Retinal fundus photograph: 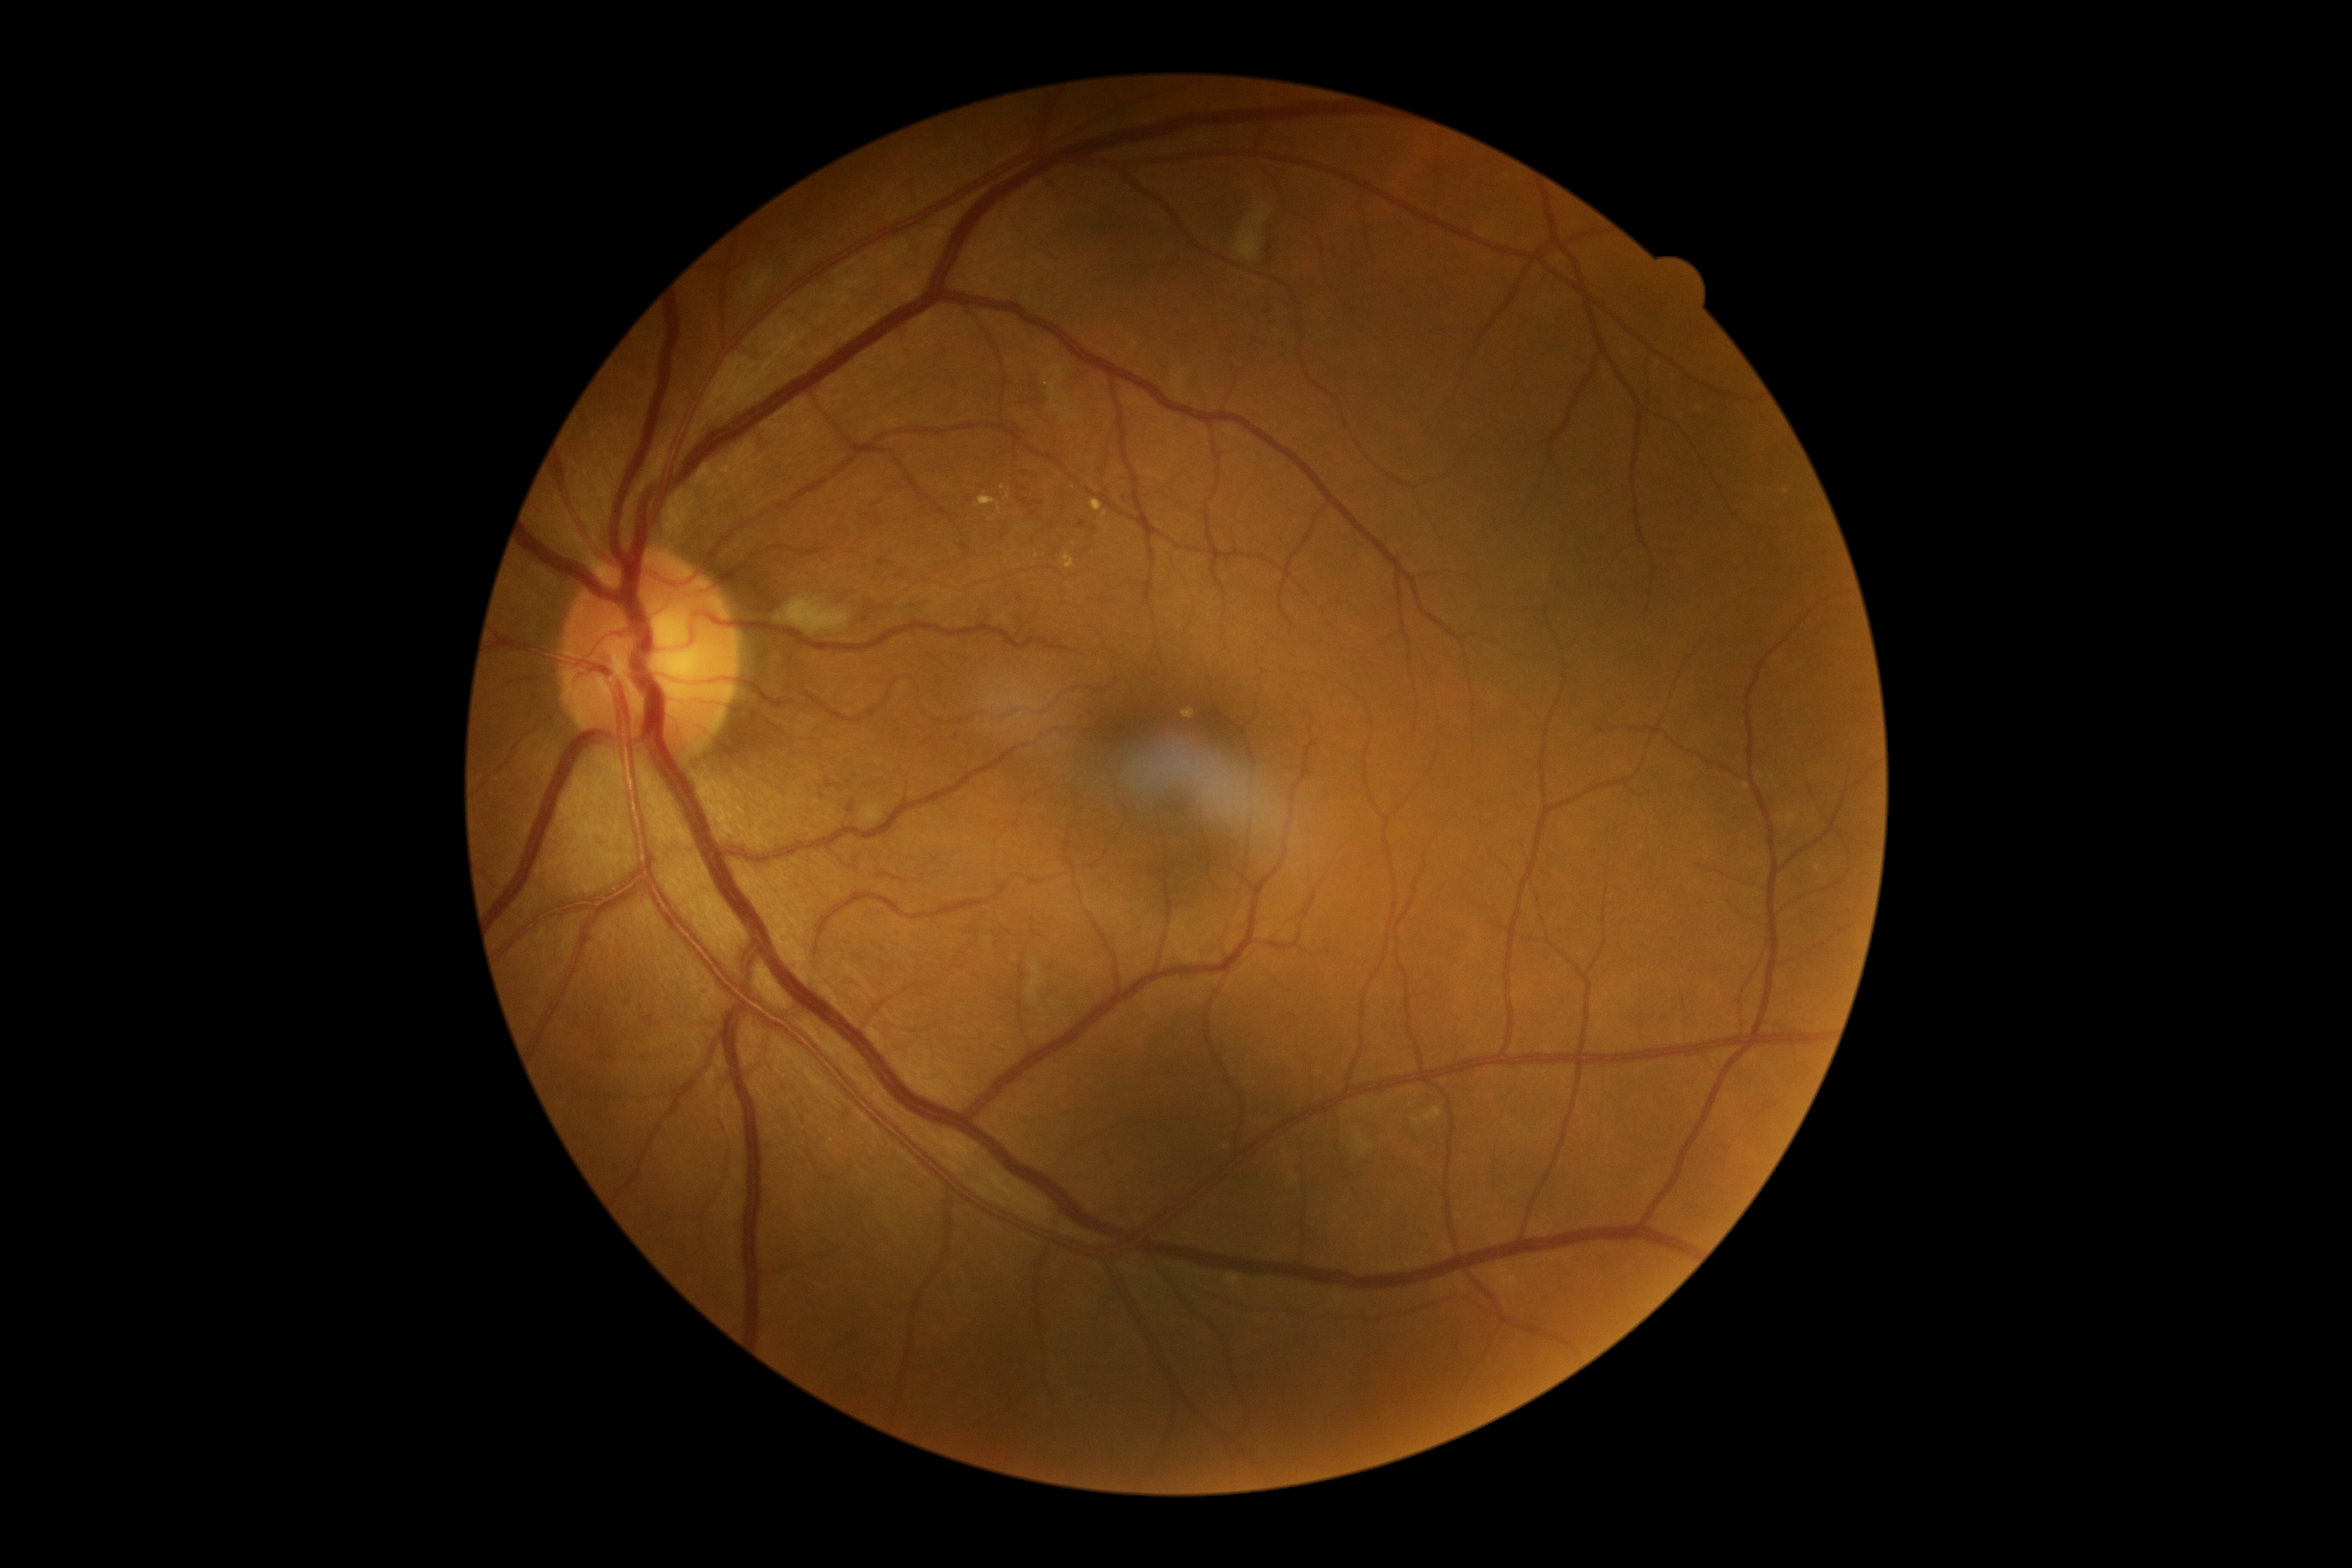

partial: true
dr_grade: 2
dr_grade_name: moderate NPDR
lesions:
  ma:
    - 960/544/969/553
    - 824/780/843/790
    - 873/501/881/508
    - 701/986/711/996
  ma_small_centers:
    - point(1125, 499)
    - point(880, 523)
    - point(1268, 312)
    - point(1092, 530)
    - point(957, 735)
    - point(1003, 536)
    - point(1272, 324)